Fundus photo. FOV: 45 degrees. Image size 2352x1568 — 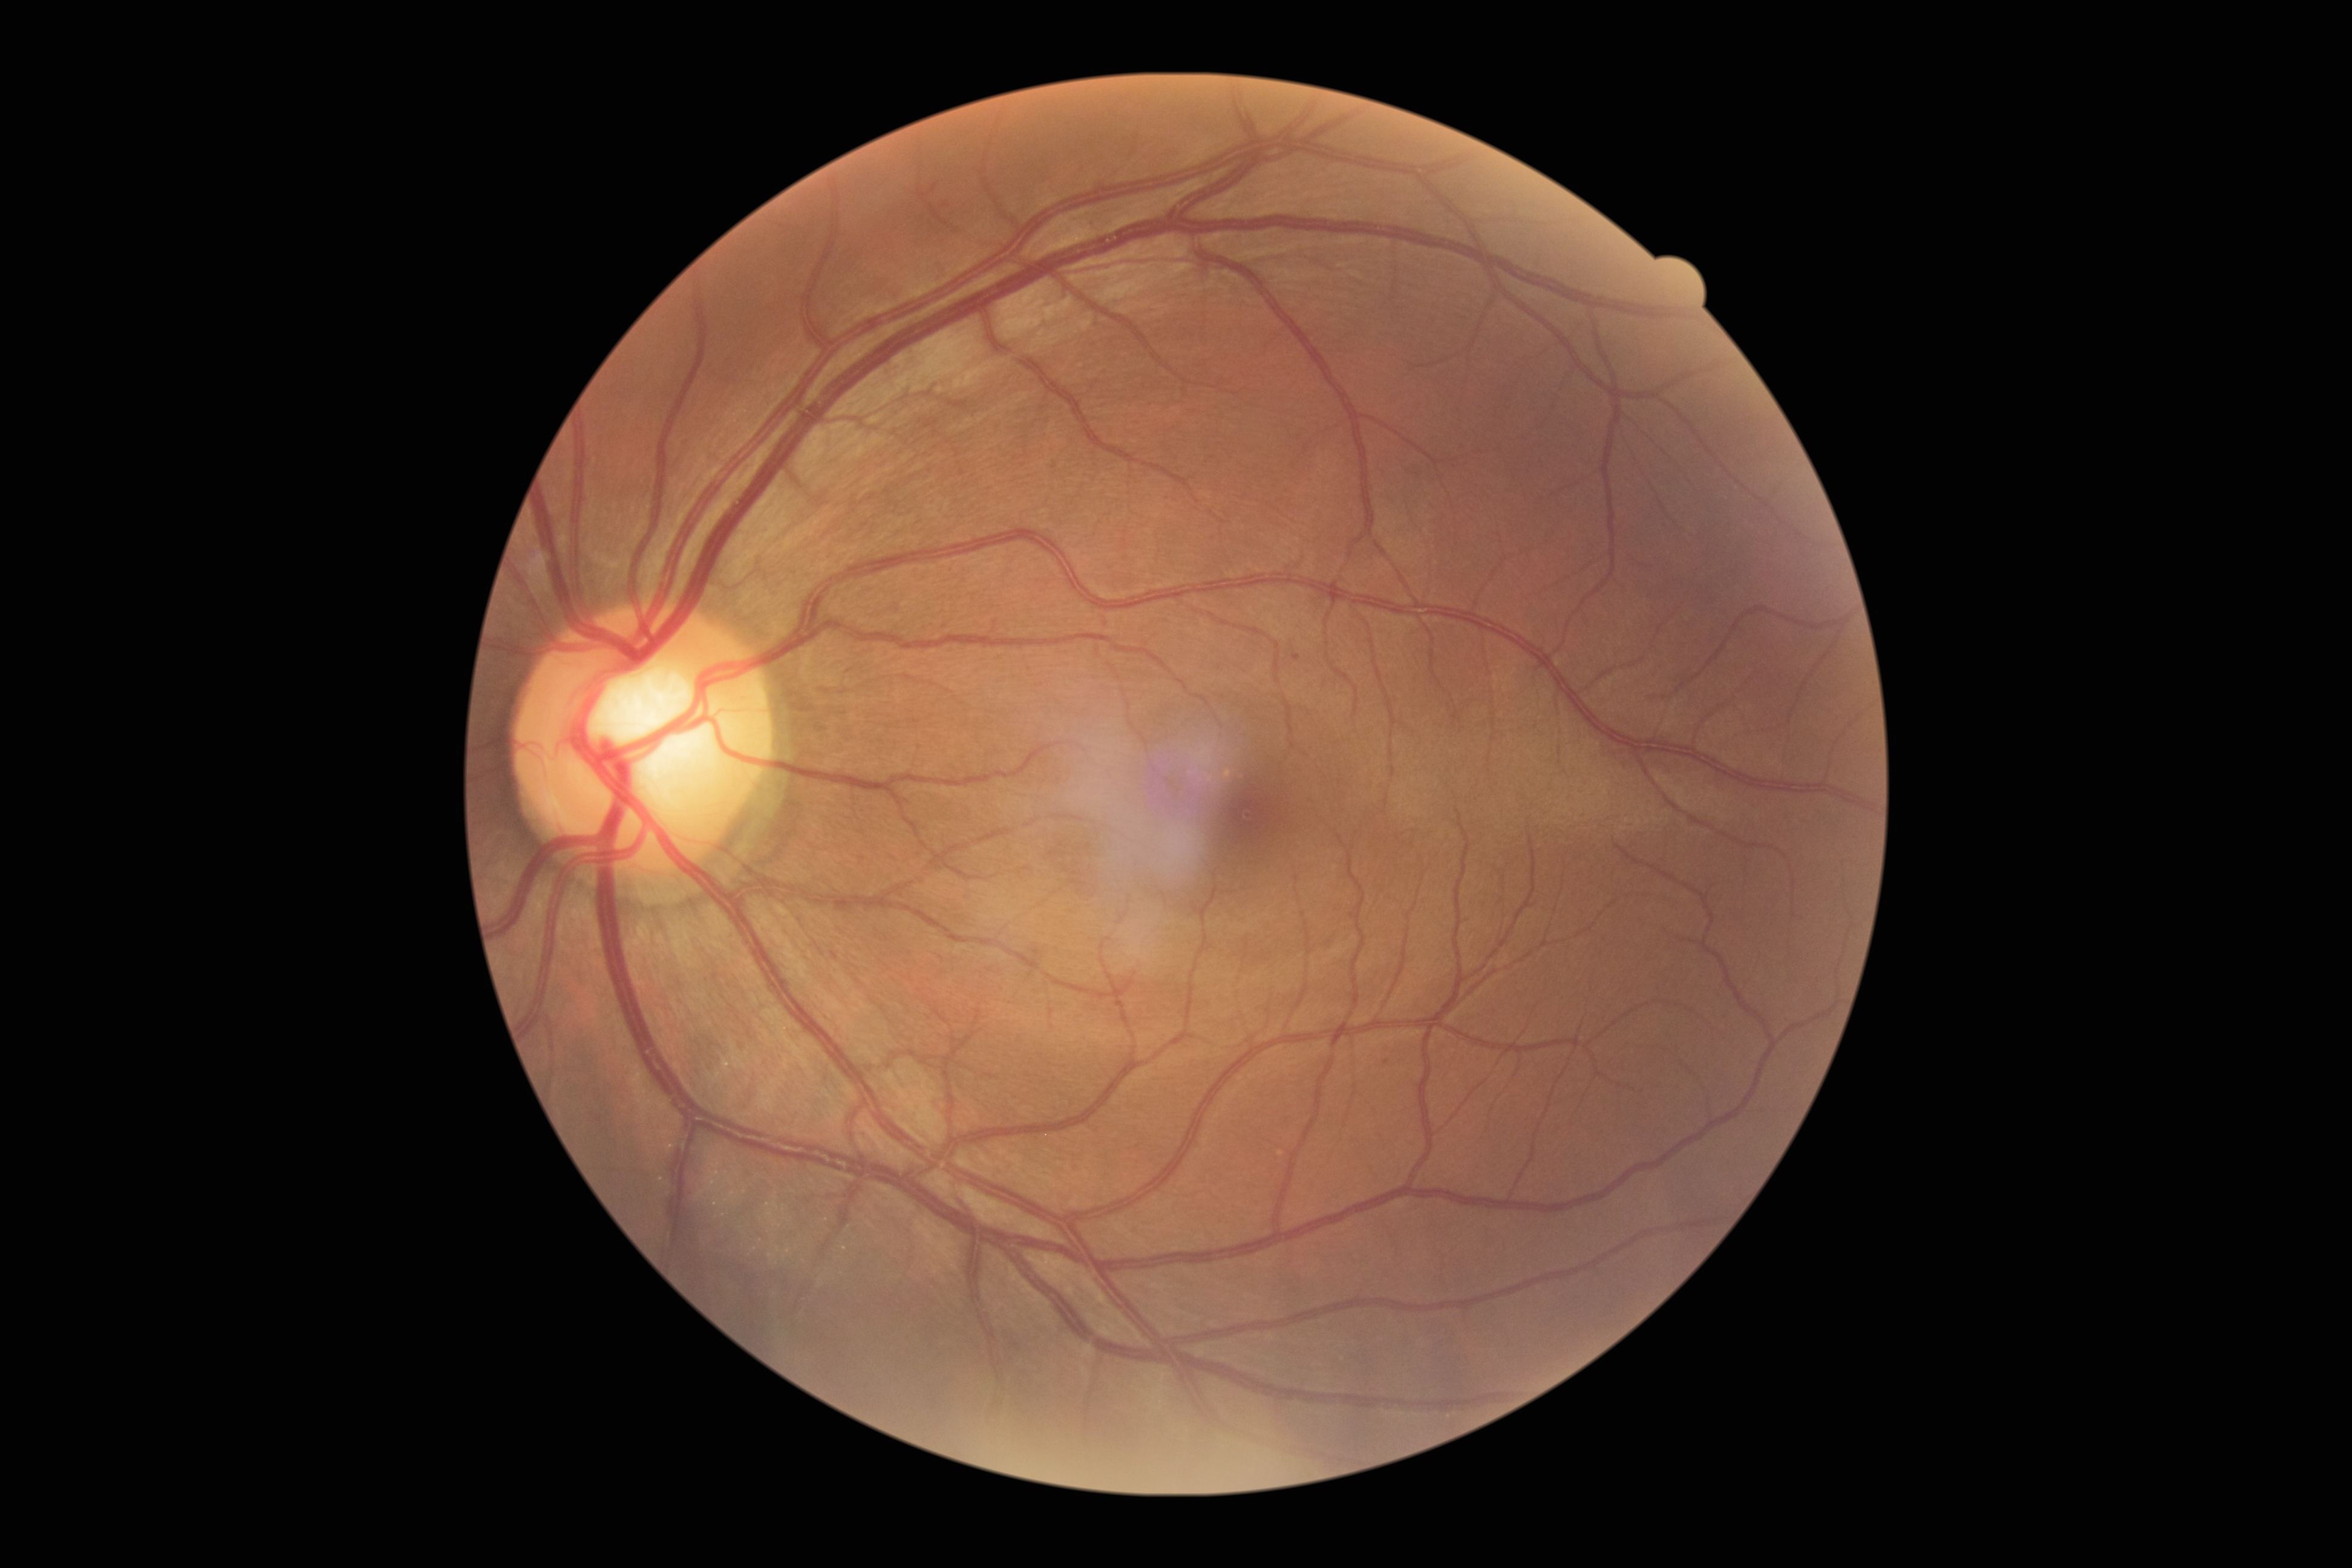

diabetic retinopathy (DR): 1/4